1932x1916; 45-degree field of view: 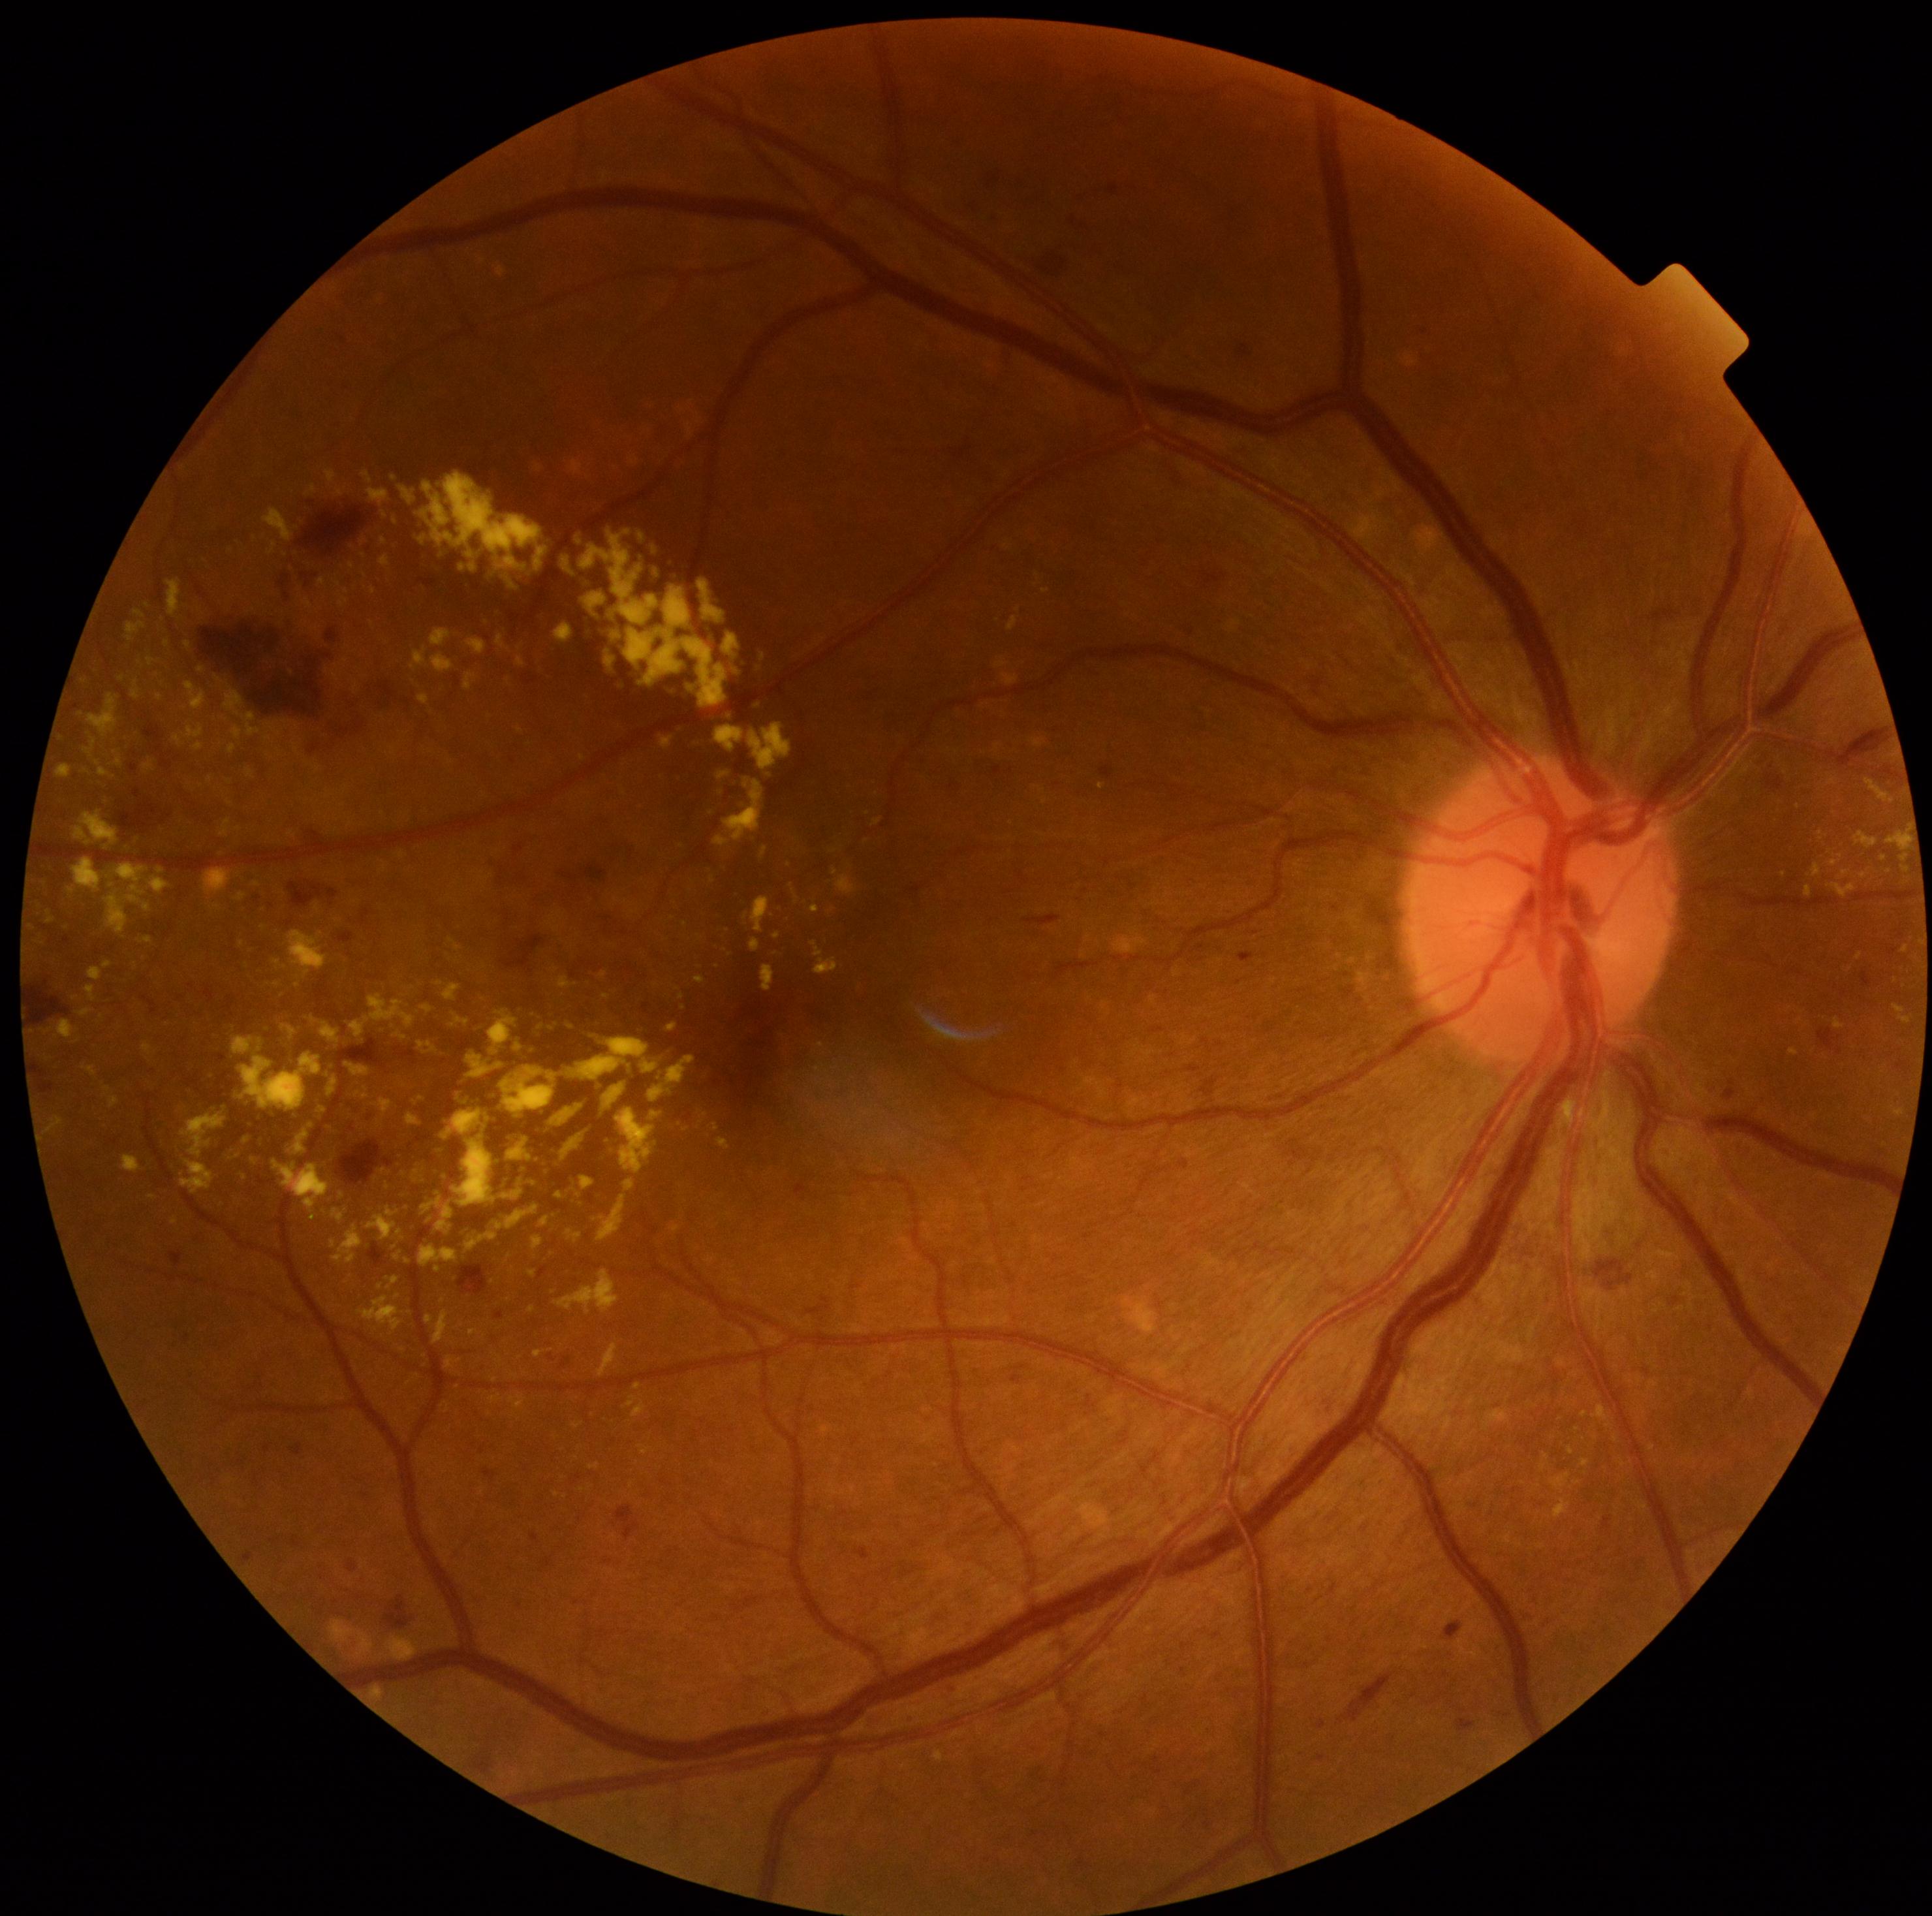

Diabetic retinopathy (DR) is grade 2
A subset of detected lesions:
hard exudates (EXs) (partial): 469:1329:477:1336; 185:641:191:650; 306:486:317:497; 443:984:461:1000; 1568:1447:1574:1456; 367:488:390:507; 390:747:397:756; 361:471:373:484; 672:1225:681:1234; 852:1325:864:1334; 716:727:743:752; 358:1296:403:1333; 86:986:97:1003; 834:868:839:876
Small EXs approximately at (x=532, y=1309); (x=365, y=575); (x=395, y=522); (x=737, y=671); (x=280, y=753)